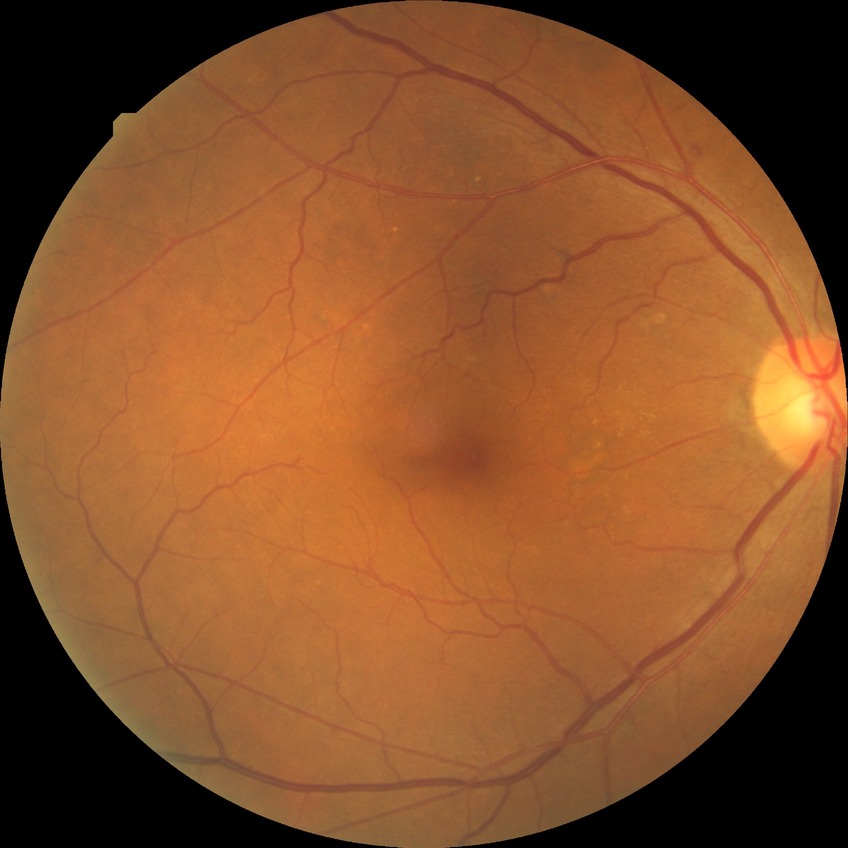
davis_grade: NDR